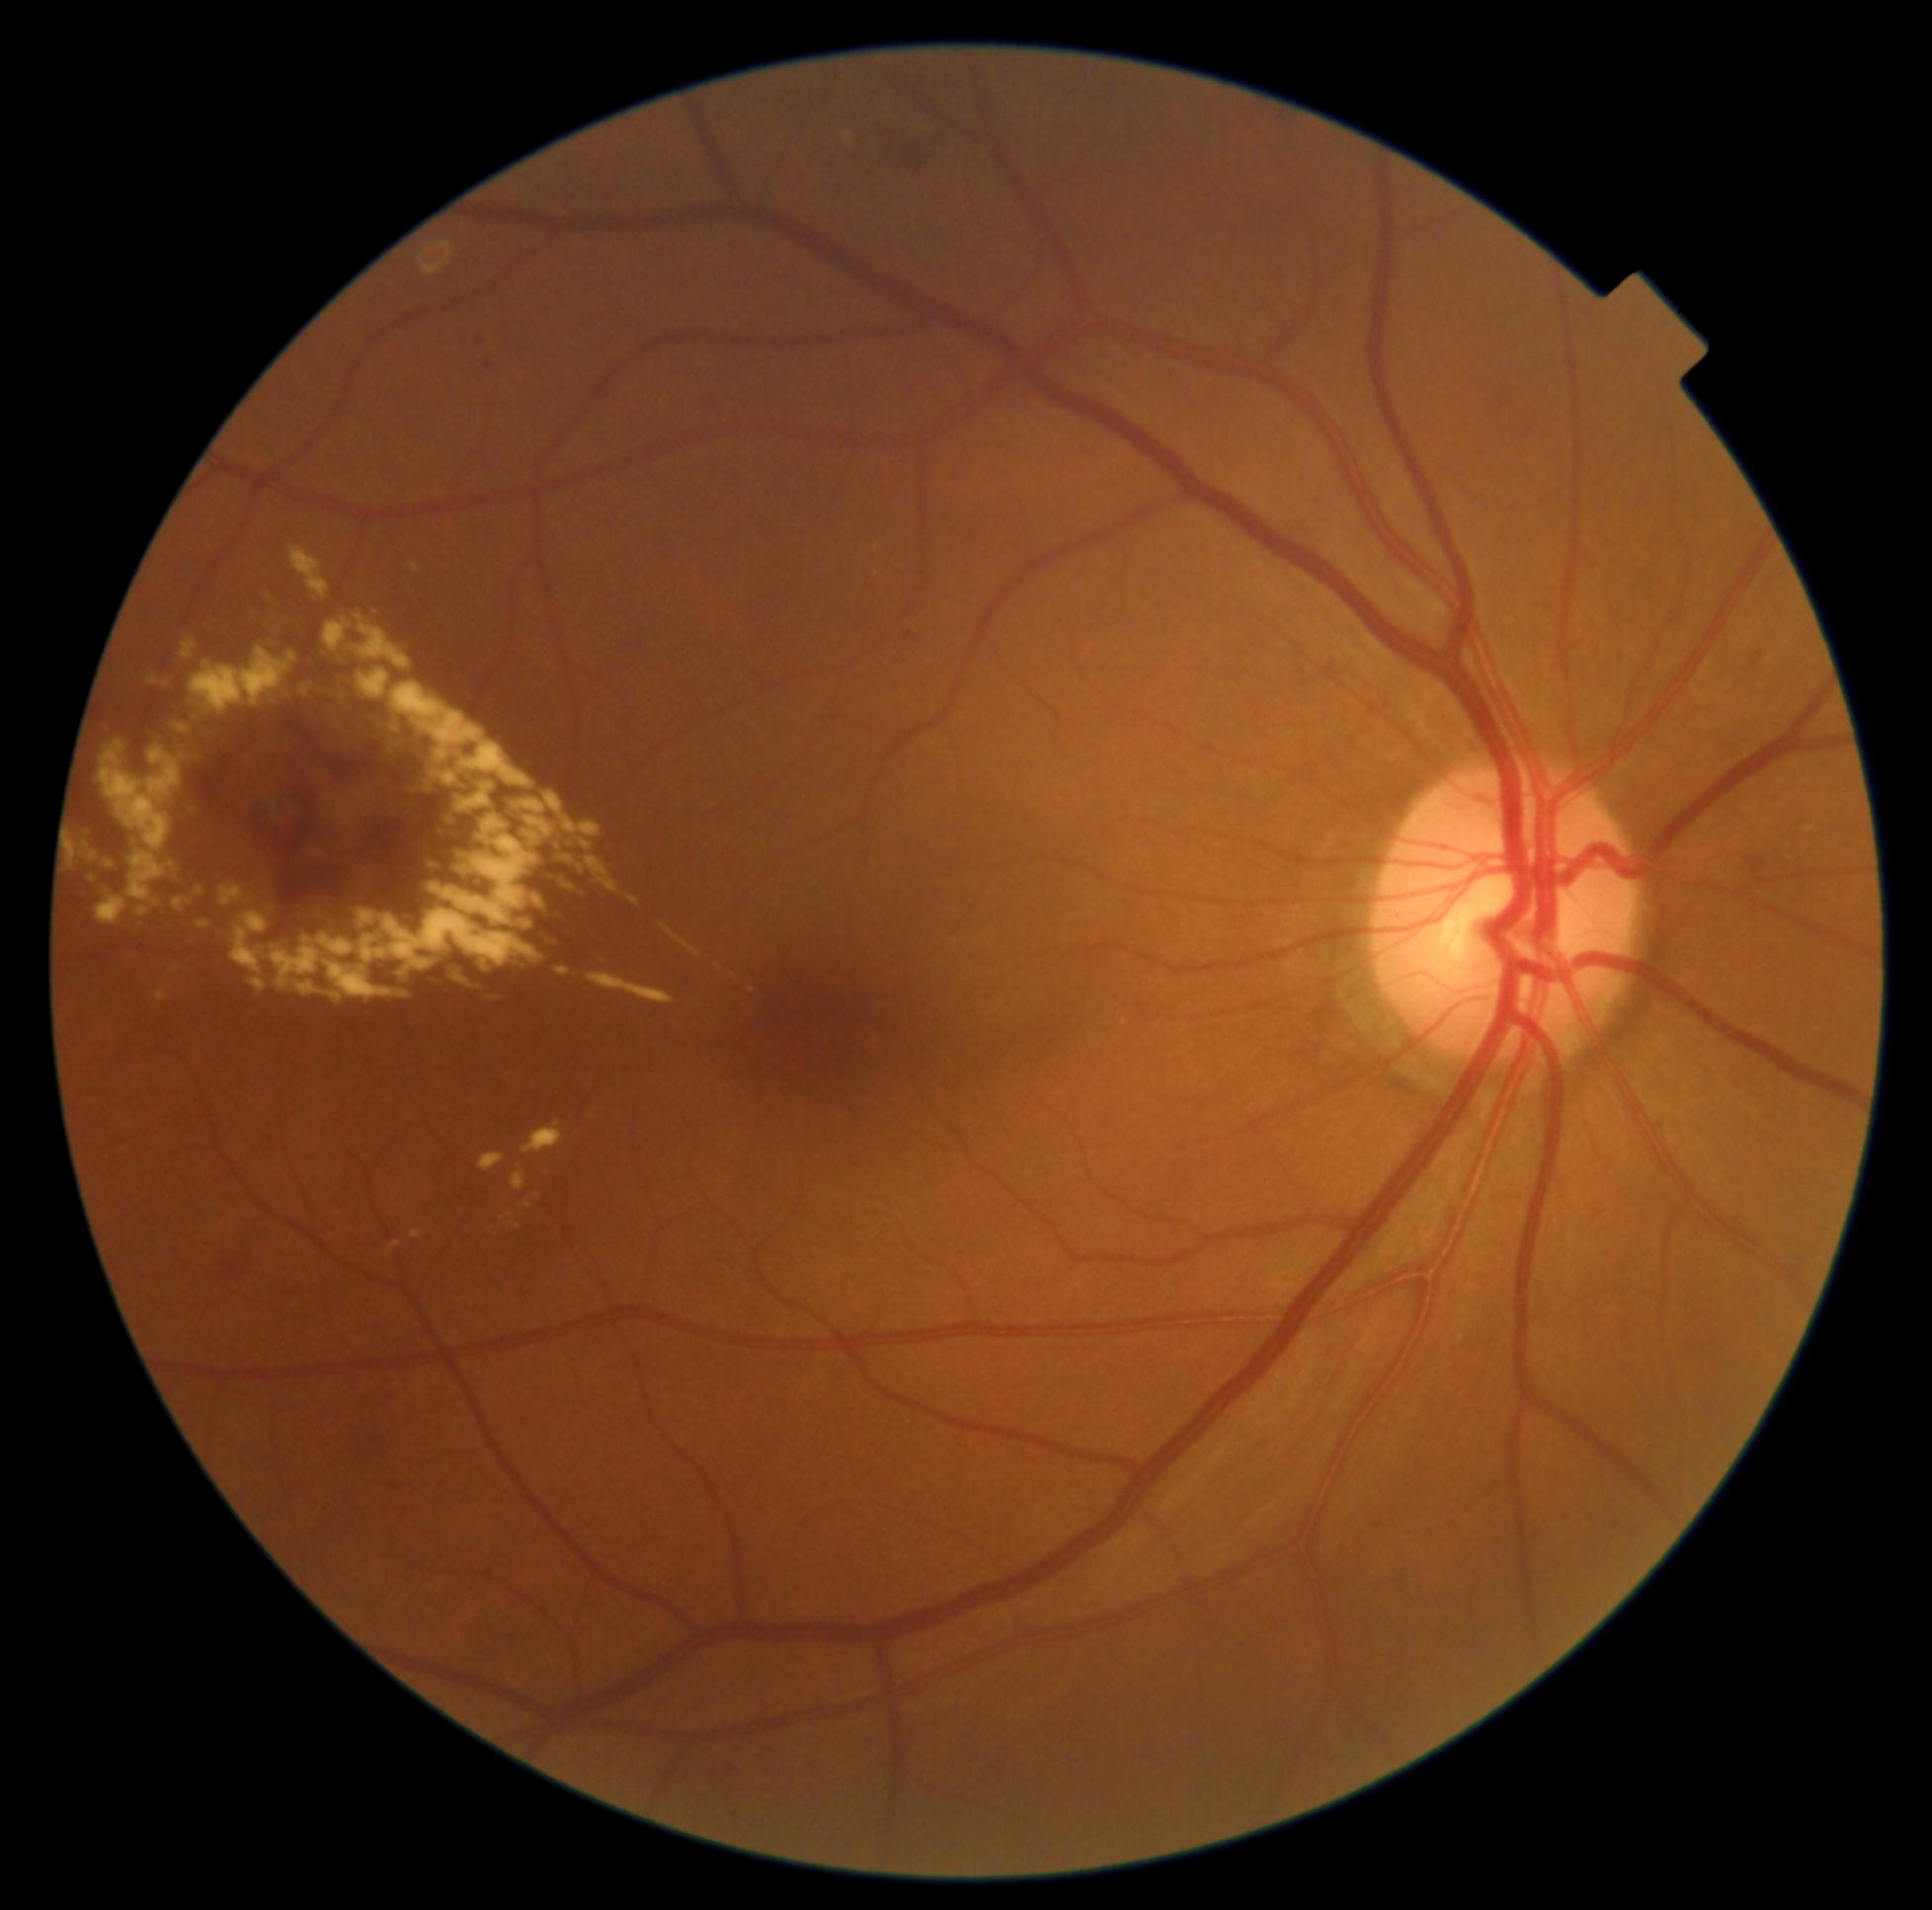 Diabetic retinopathy (DR): grade 2 (moderate NPDR).
Hard exudates (EXs) (partial list) at (96, 895, 128, 925) | (523, 1120, 566, 1154) | (146, 673, 159, 685) | (555, 842, 566, 852) | (582, 841, 593, 850) | (381, 719, 403, 738) | (78, 836, 91, 846) | (512, 791, 564, 846) | (390, 681, 535, 789) | (424, 861, 445, 872) | (487, 992, 510, 1000) | (175, 725, 190, 734) | (564, 820, 602, 837).
Additional small EXs near pt(175, 970) | pt(569, 887) | pt(733, 976) | pt(273, 794).